45° FOV — 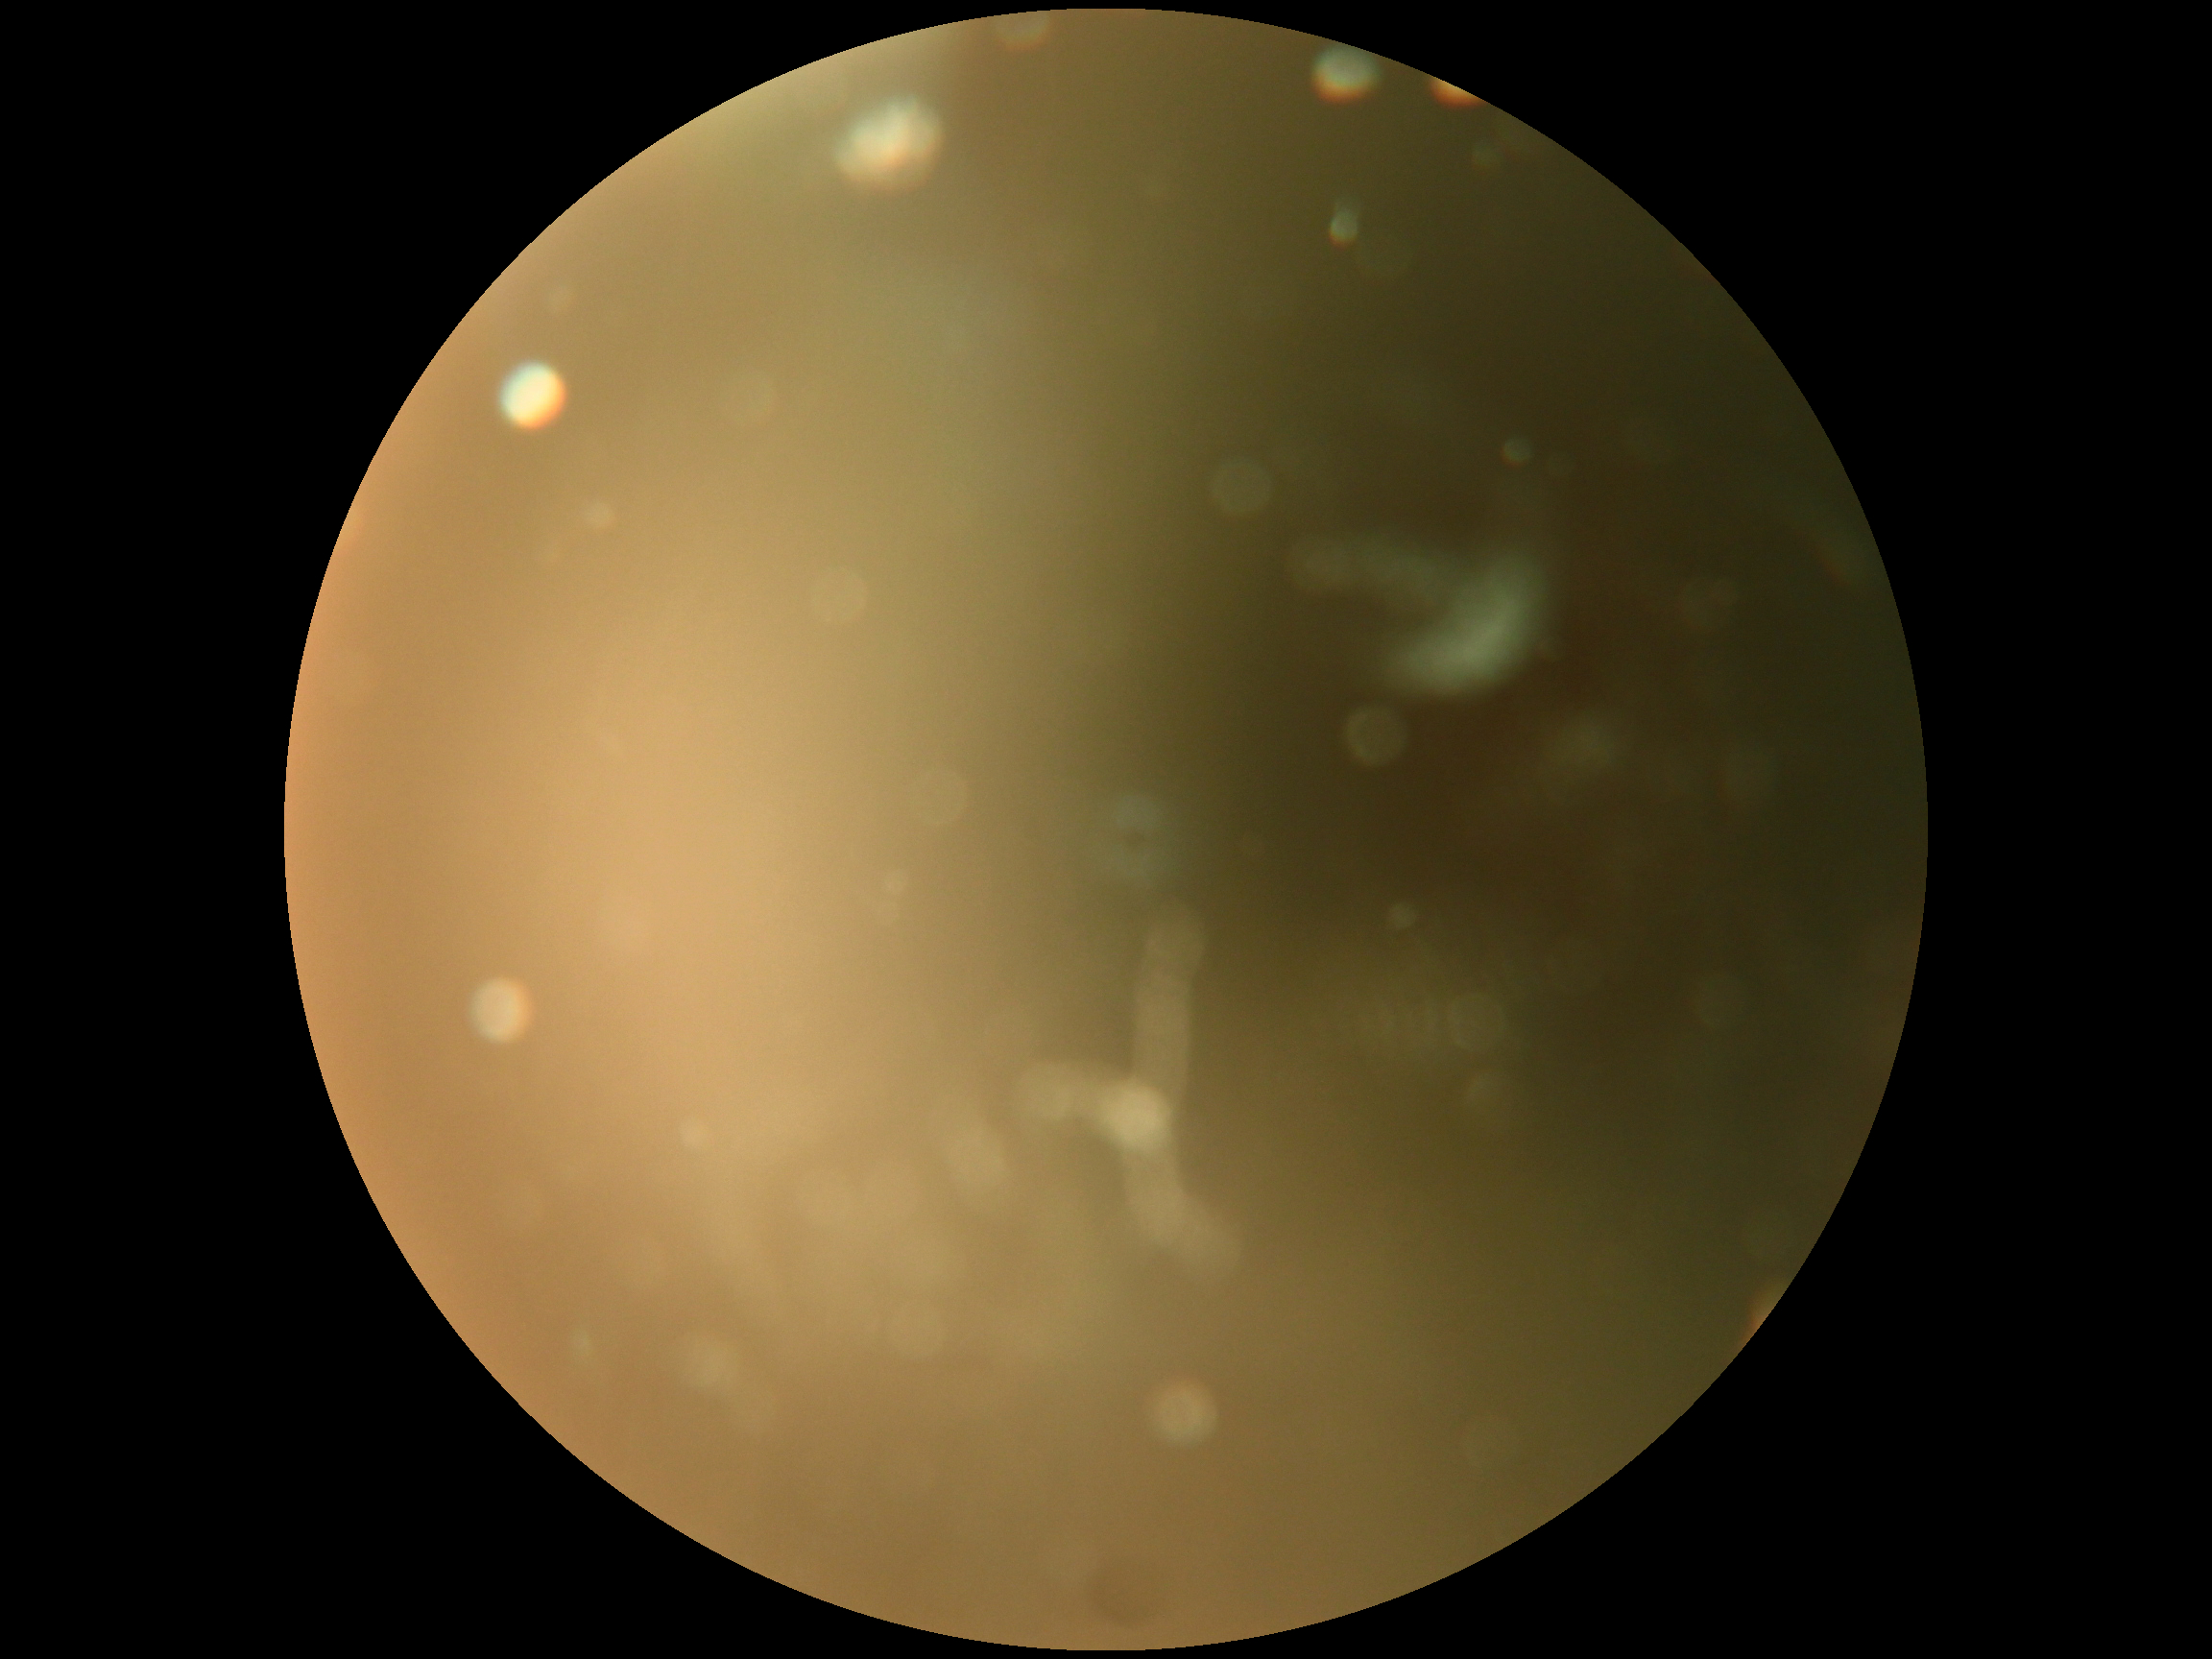 Quality too poor to assess for DR.
Diabetic retinopathy (DR) is ungradable due to poor image quality.